Camera: NIDEK AFC-230.
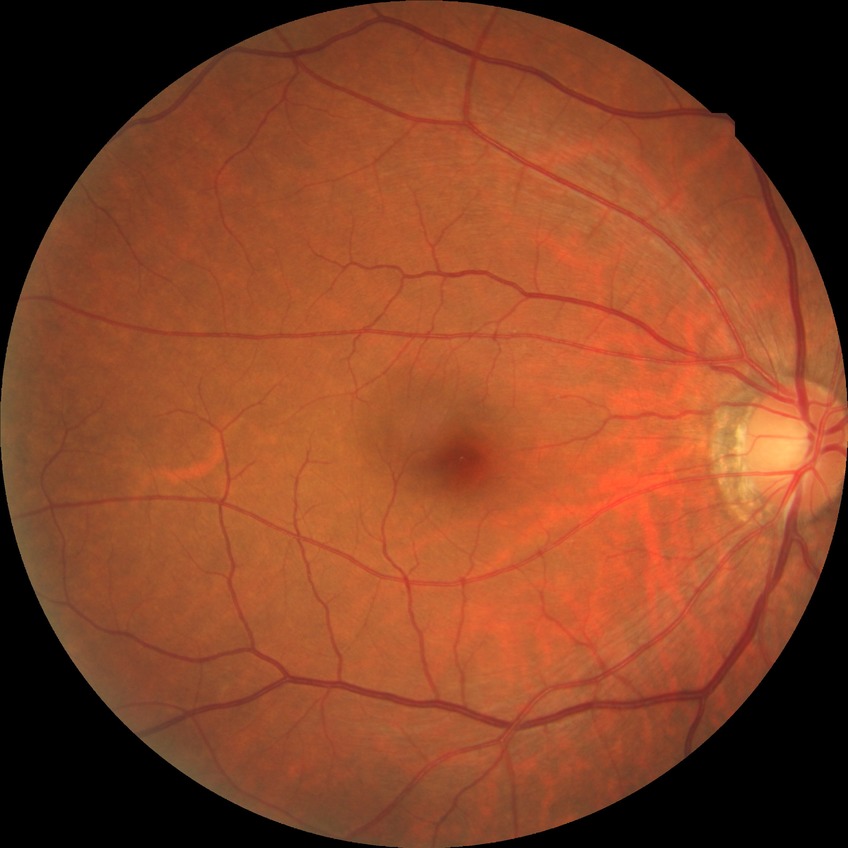 Diabetic retinopathy (DR): NDR (no diabetic retinopathy).